Ultra-widefield fundus mosaic, 200-degree field of view:
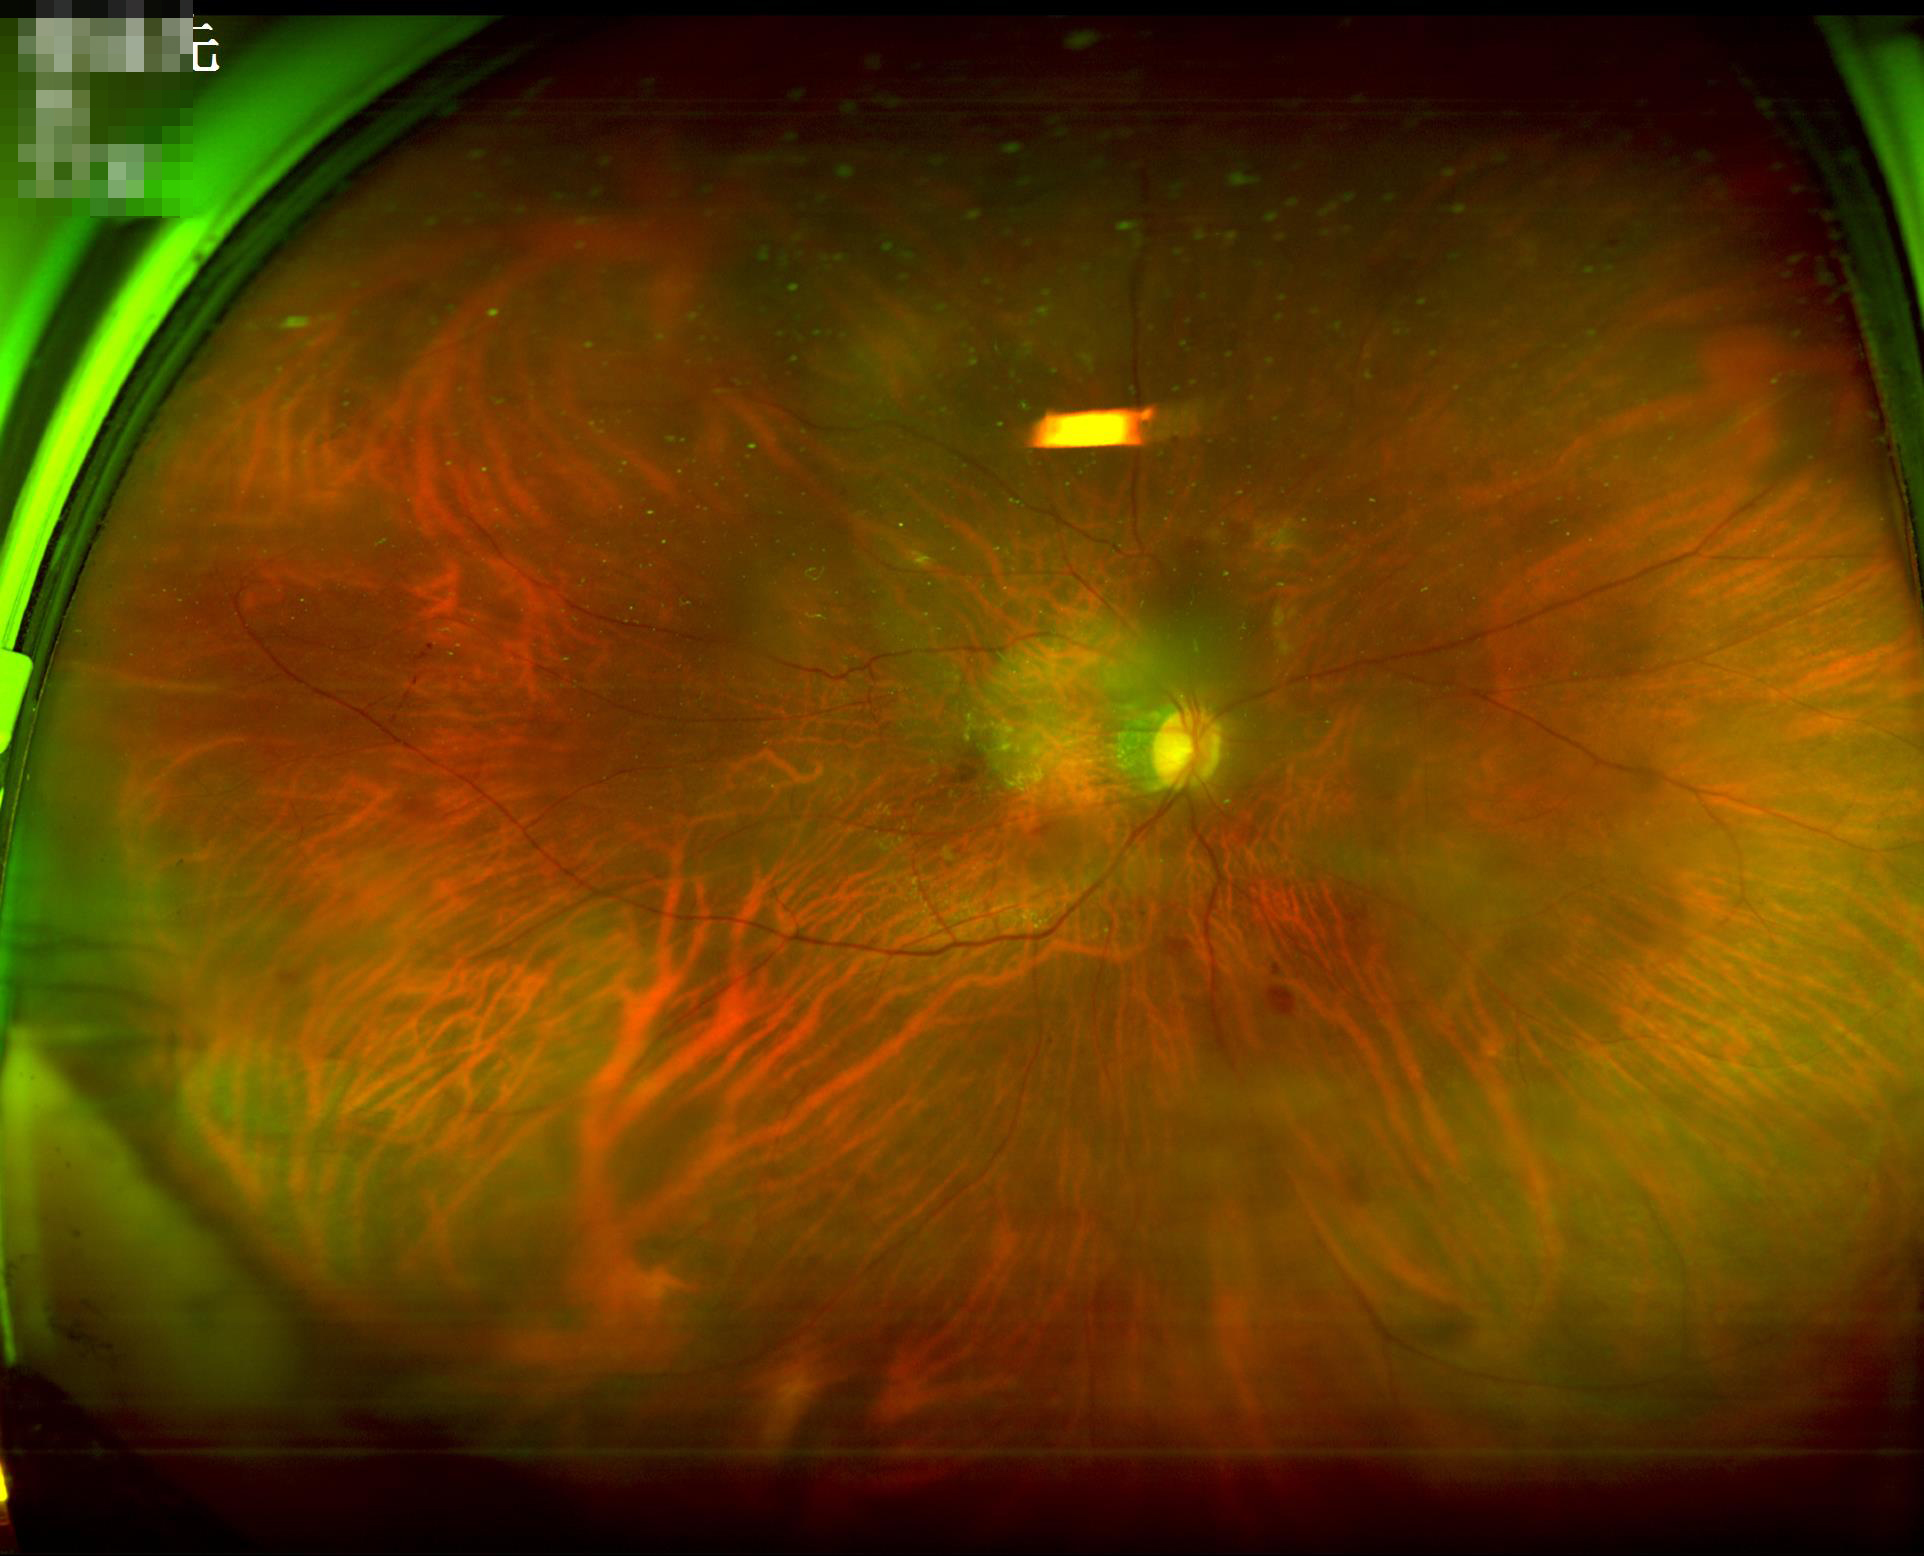
{"clarity": "reduced sharpness with visible blur", "illumination": "no over- or under-exposure", "overall_quality": "good, gradable"}